Clarity RetCam 3, 130° FOV · wide-field fundus photograph of an infant
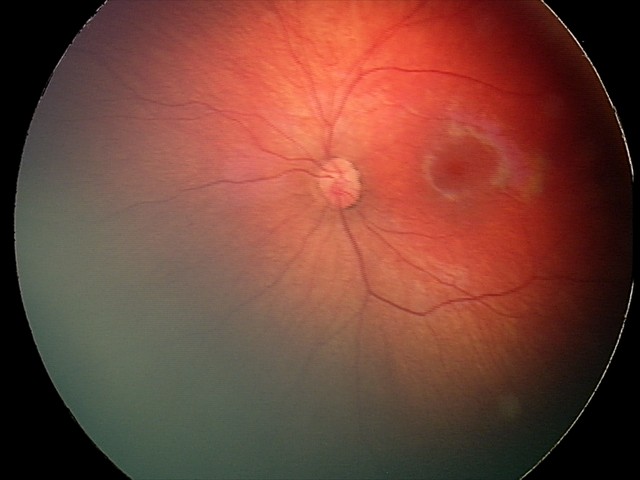

Screening series with retinal hemorrhages.